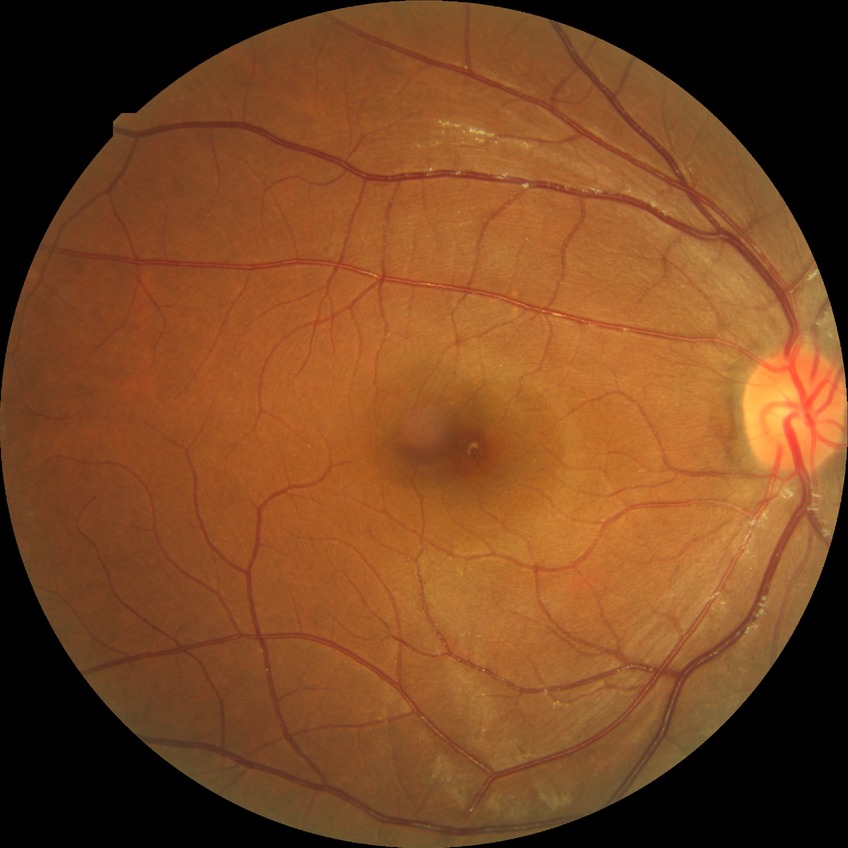 No diabetic retinal disease findings.
Davis grade: NDR.